45° FOV:
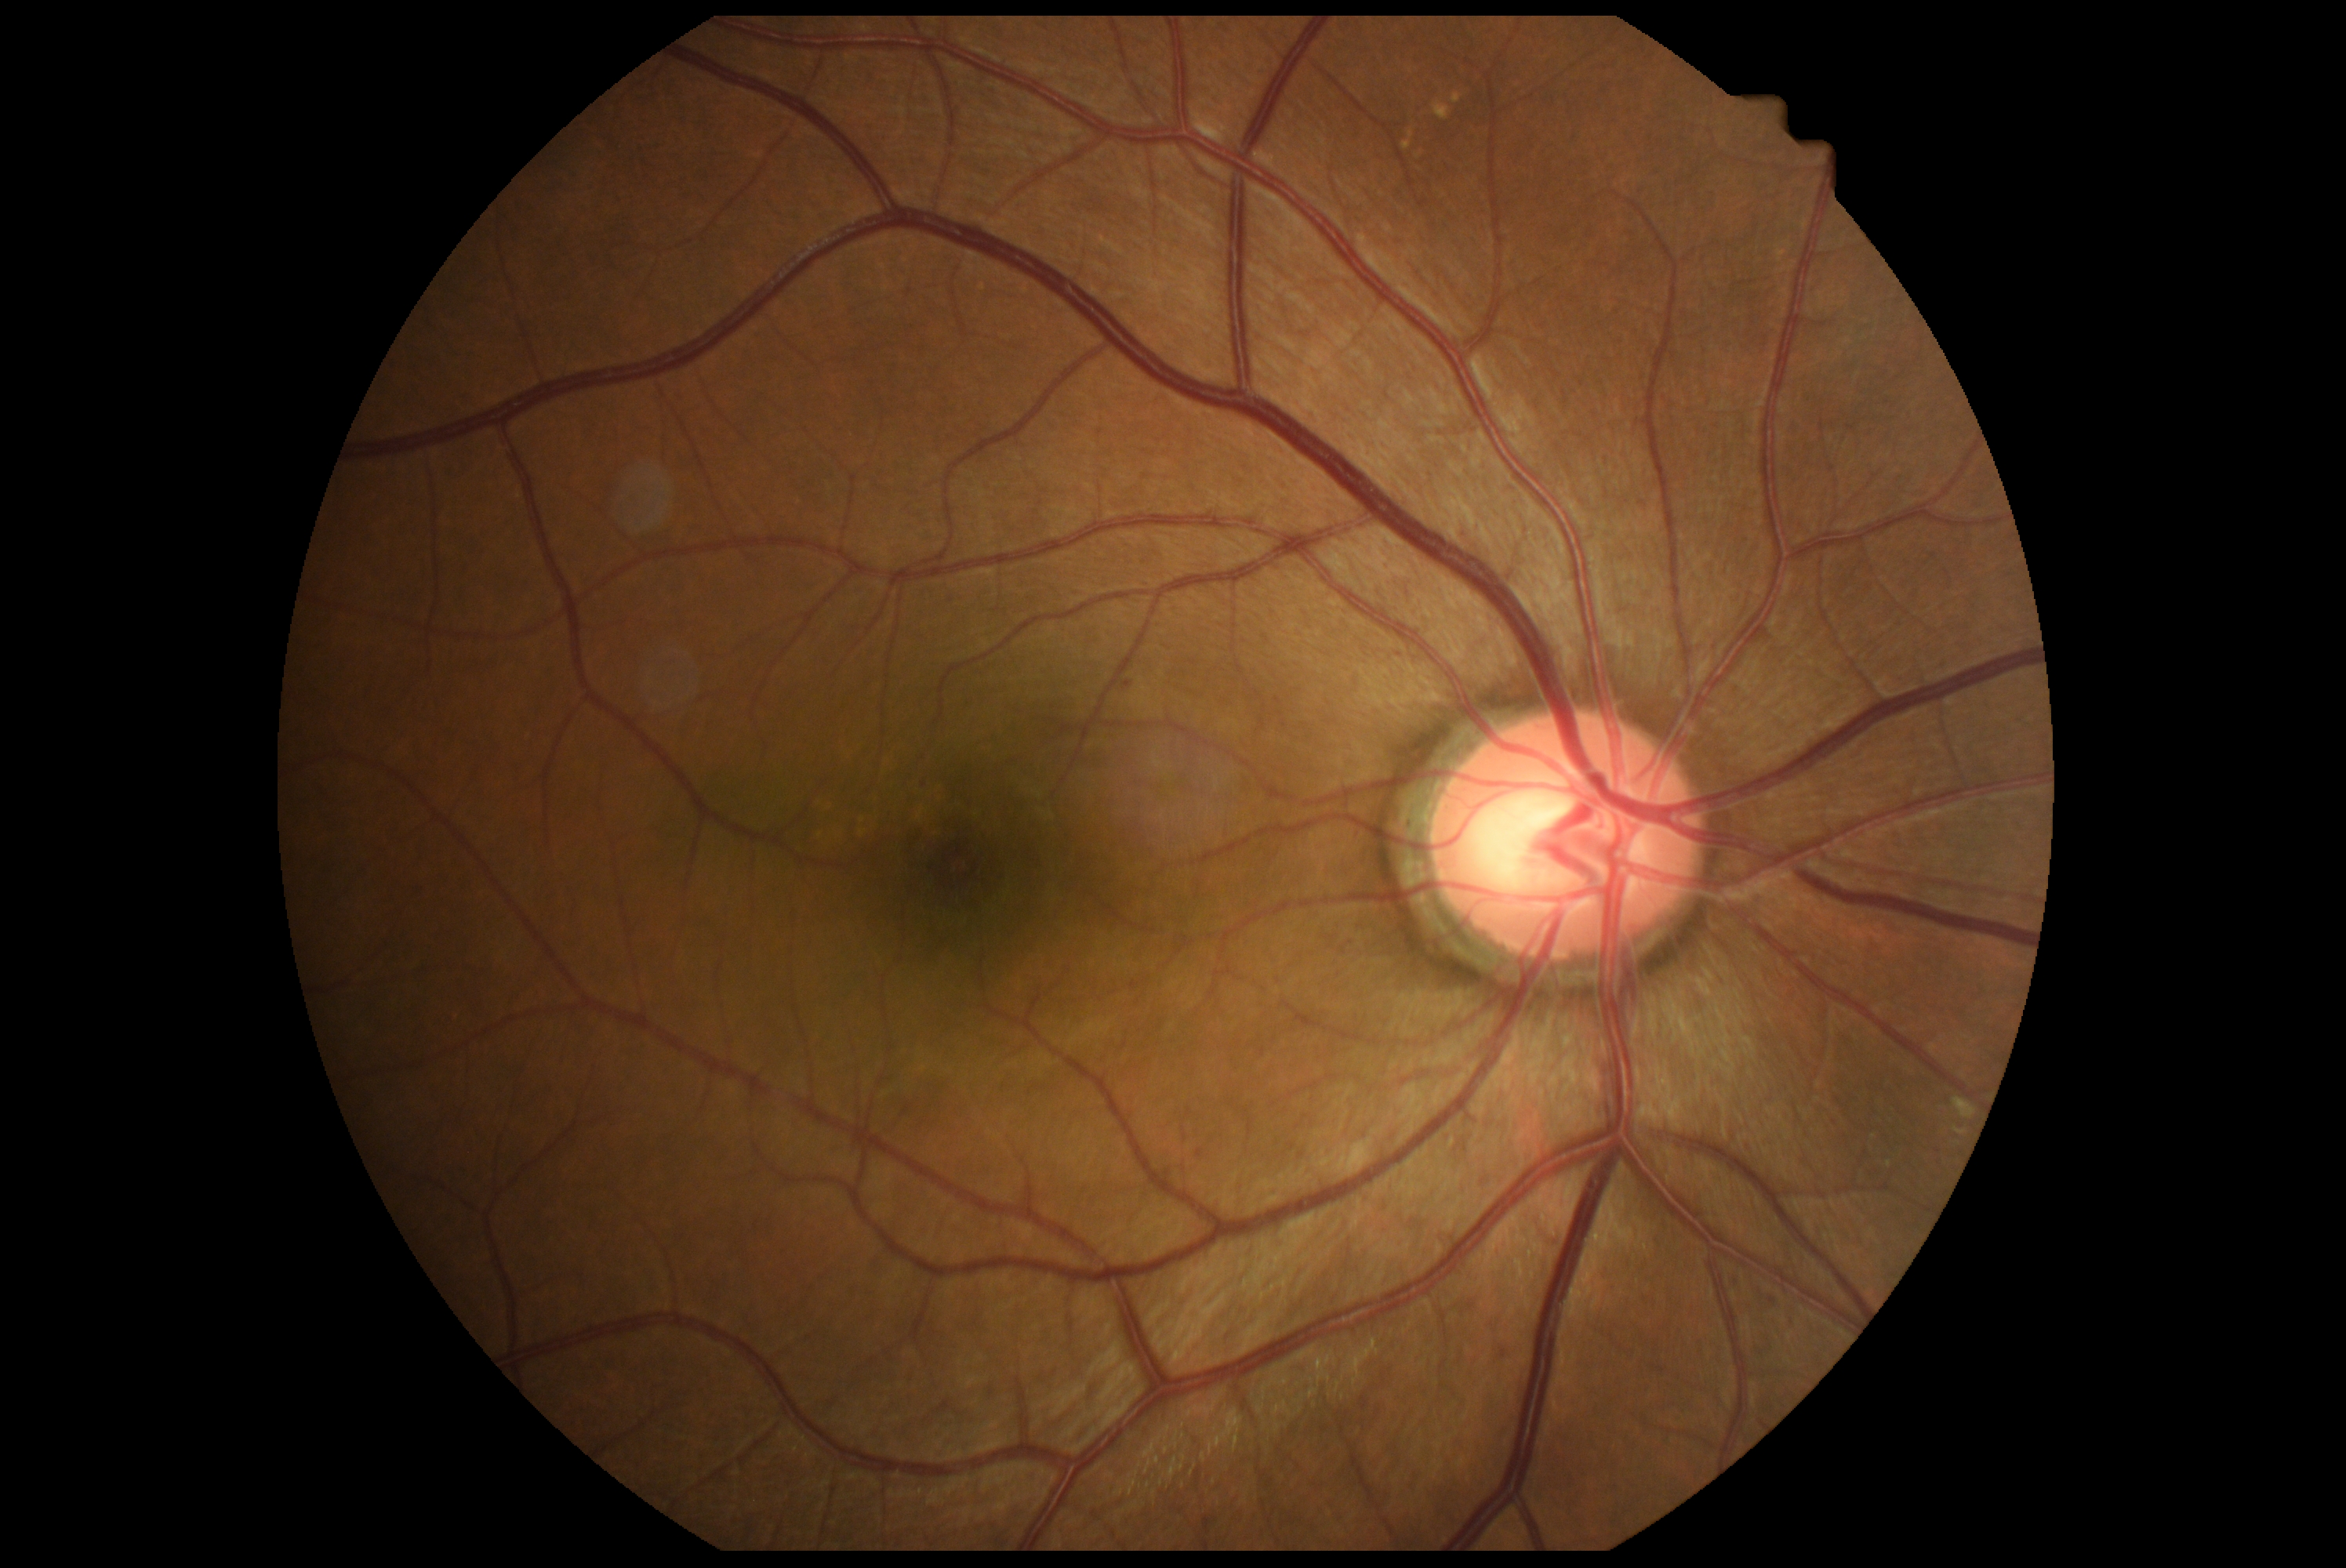

diabetic retinopathy = 2
DR class = non-proliferative diabetic retinopathy